2361x1568px. Fundus photo. Macula at the center of the field. Mydriatic (tropicamide 0.5%). 50° FOV: 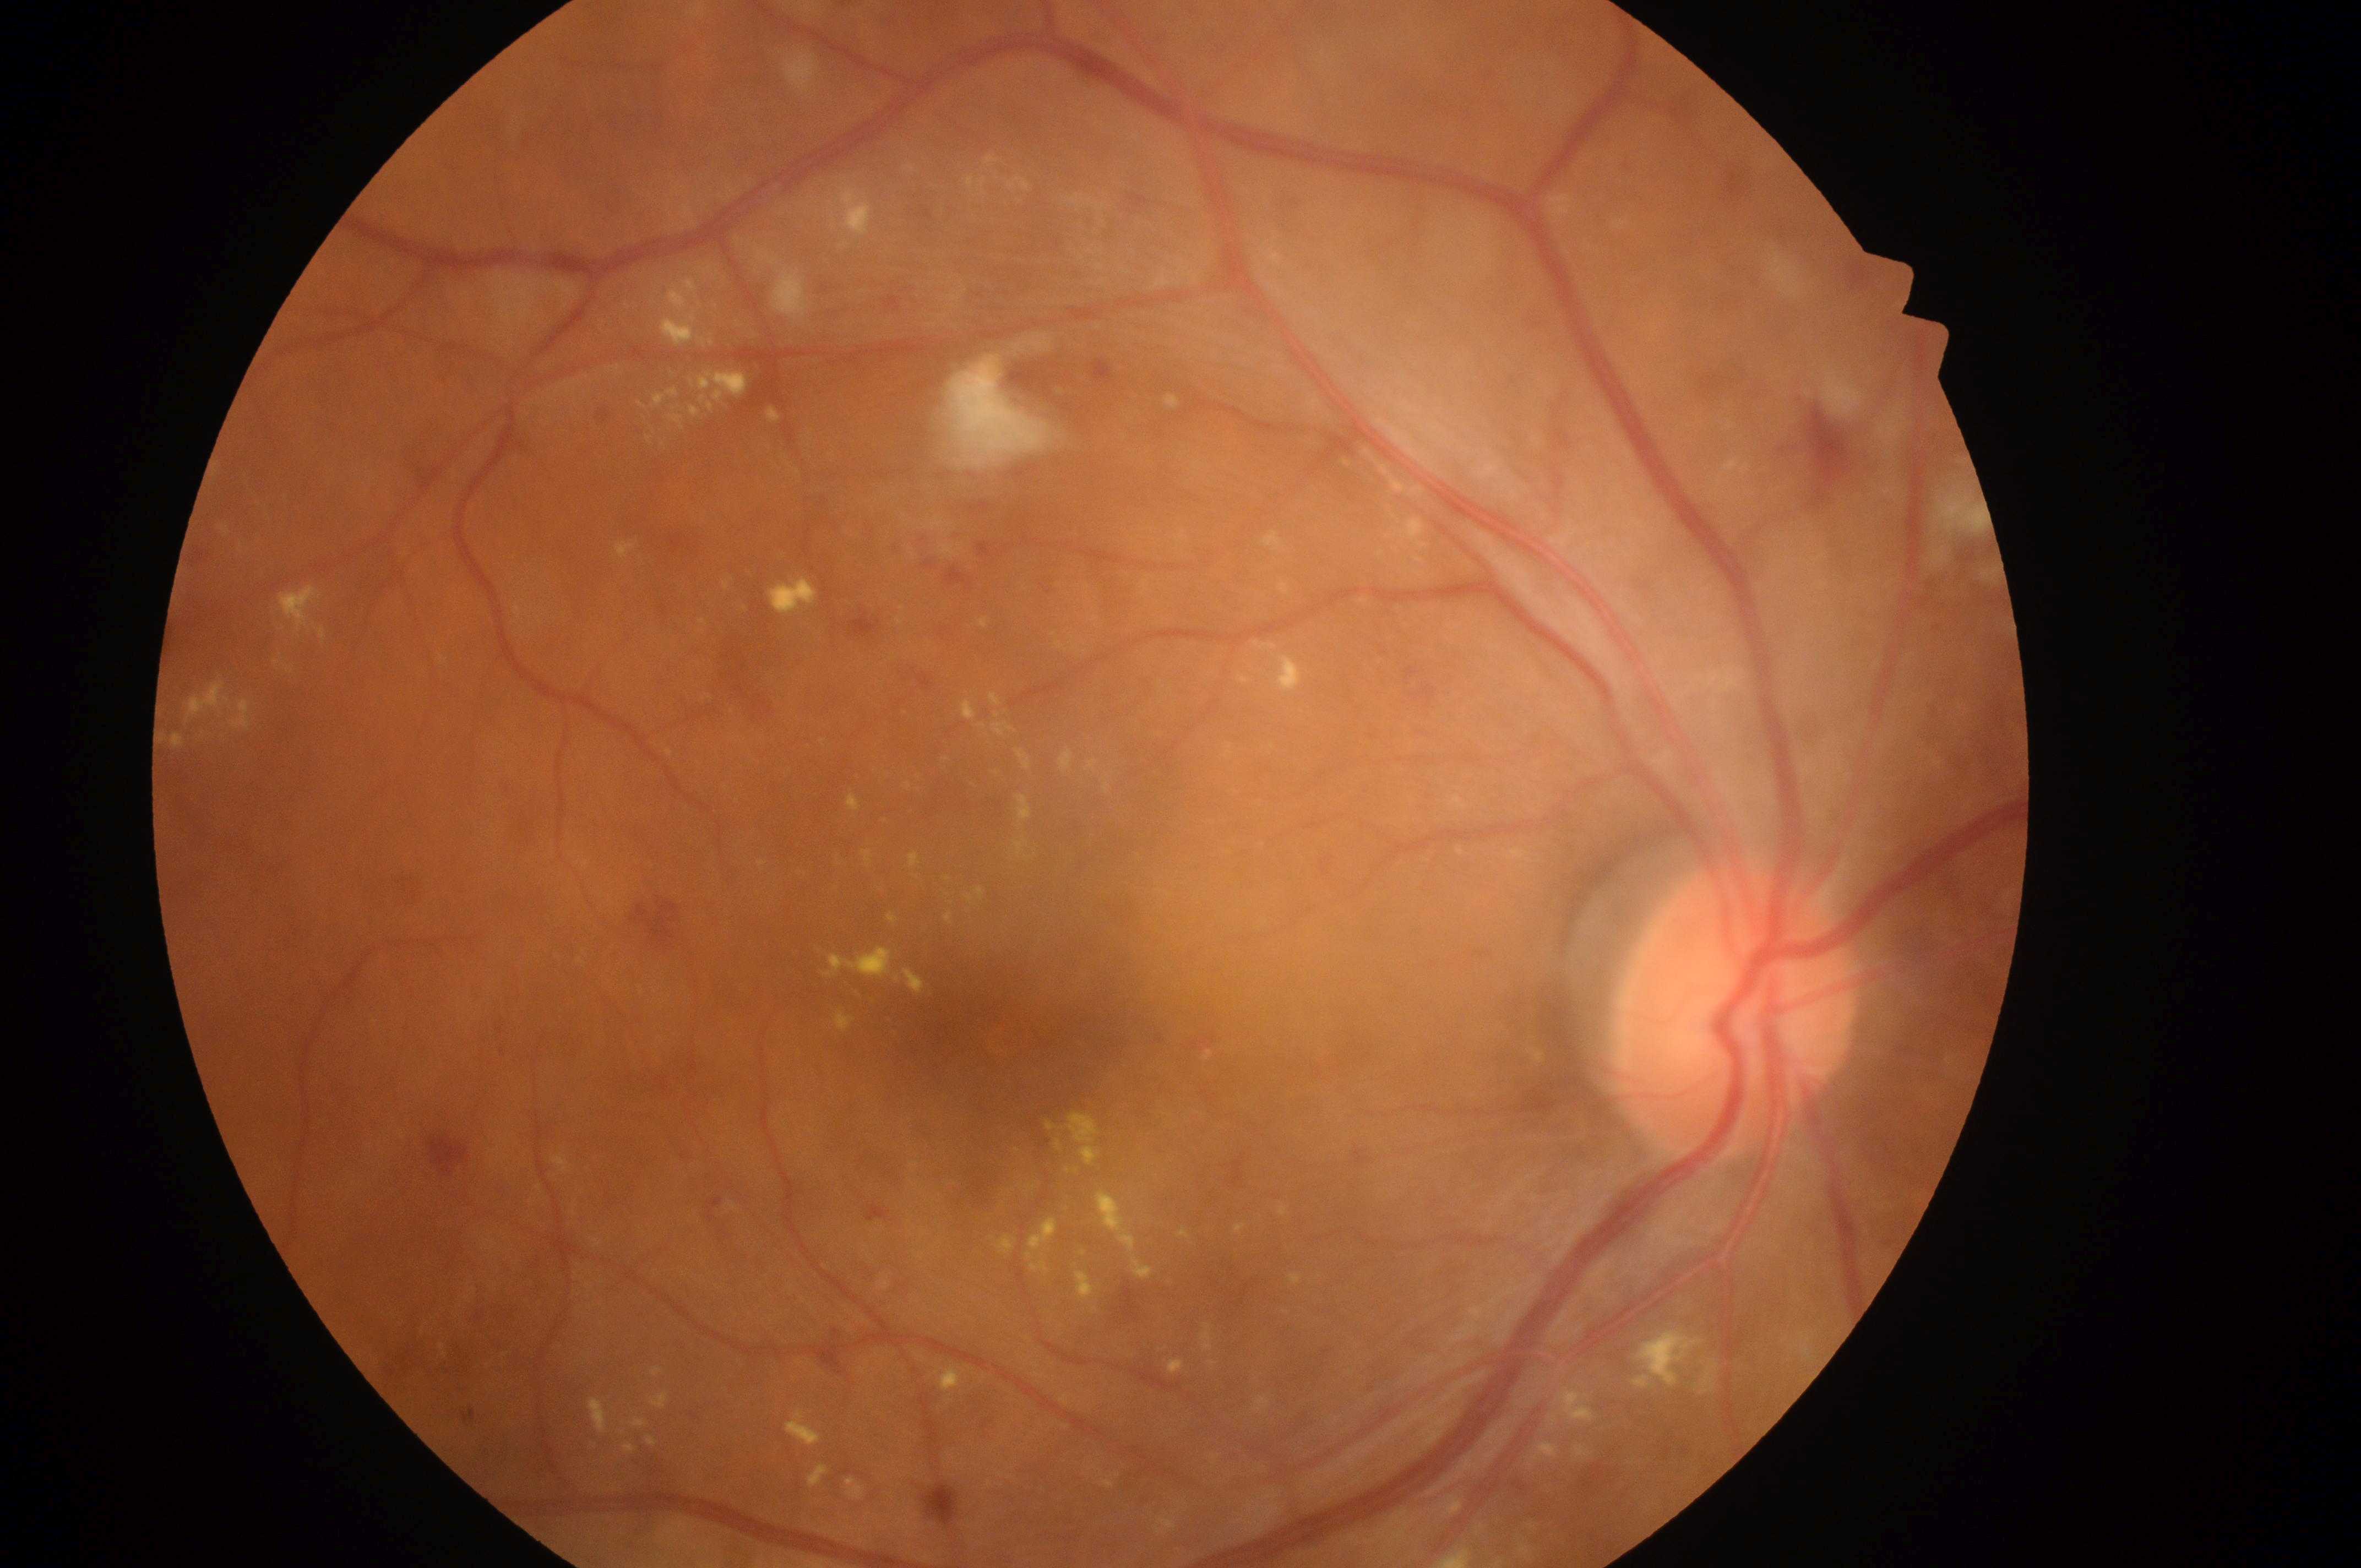

Q: DR stage?
A: 2
Q: Optic disc center?
A: 1728px, 1021px
Q: What disease class is present?
A: non-proliferative diabetic retinopathy
Q: Fovea center?
A: 1021px, 1035px
Q: What is the DME risk grade?
A: grade 2
Q: What is the laterality?
A: right eye